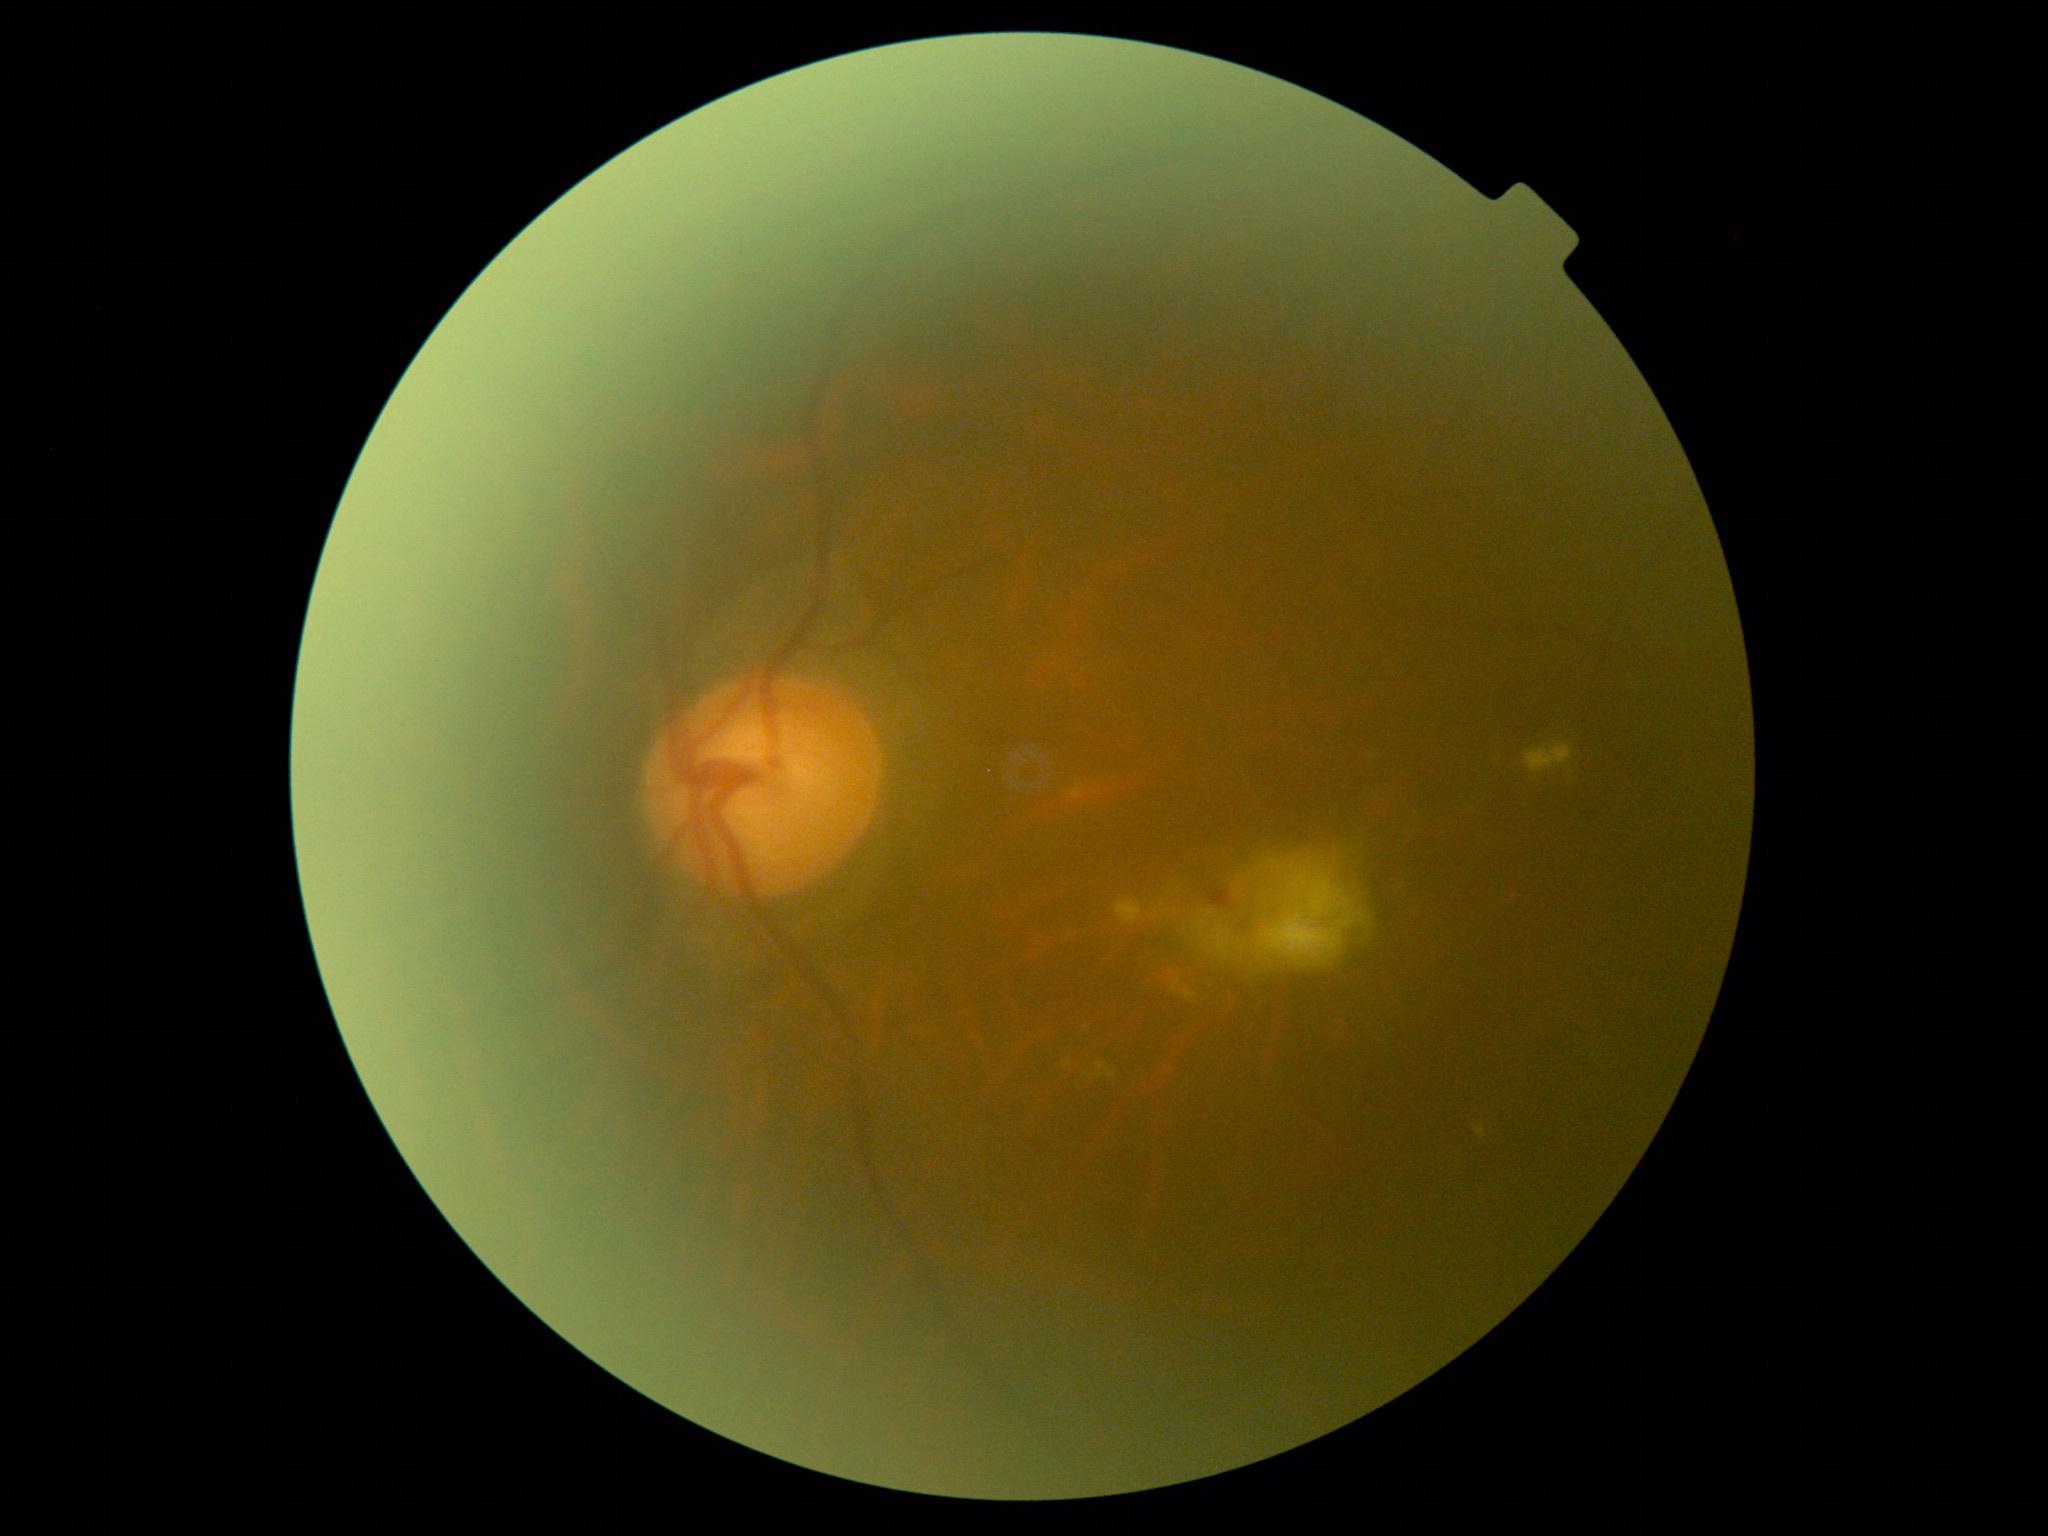 DR class: non-proliferative diabetic retinopathy. Diabetic retinopathy is moderate NPDR (grade 2).